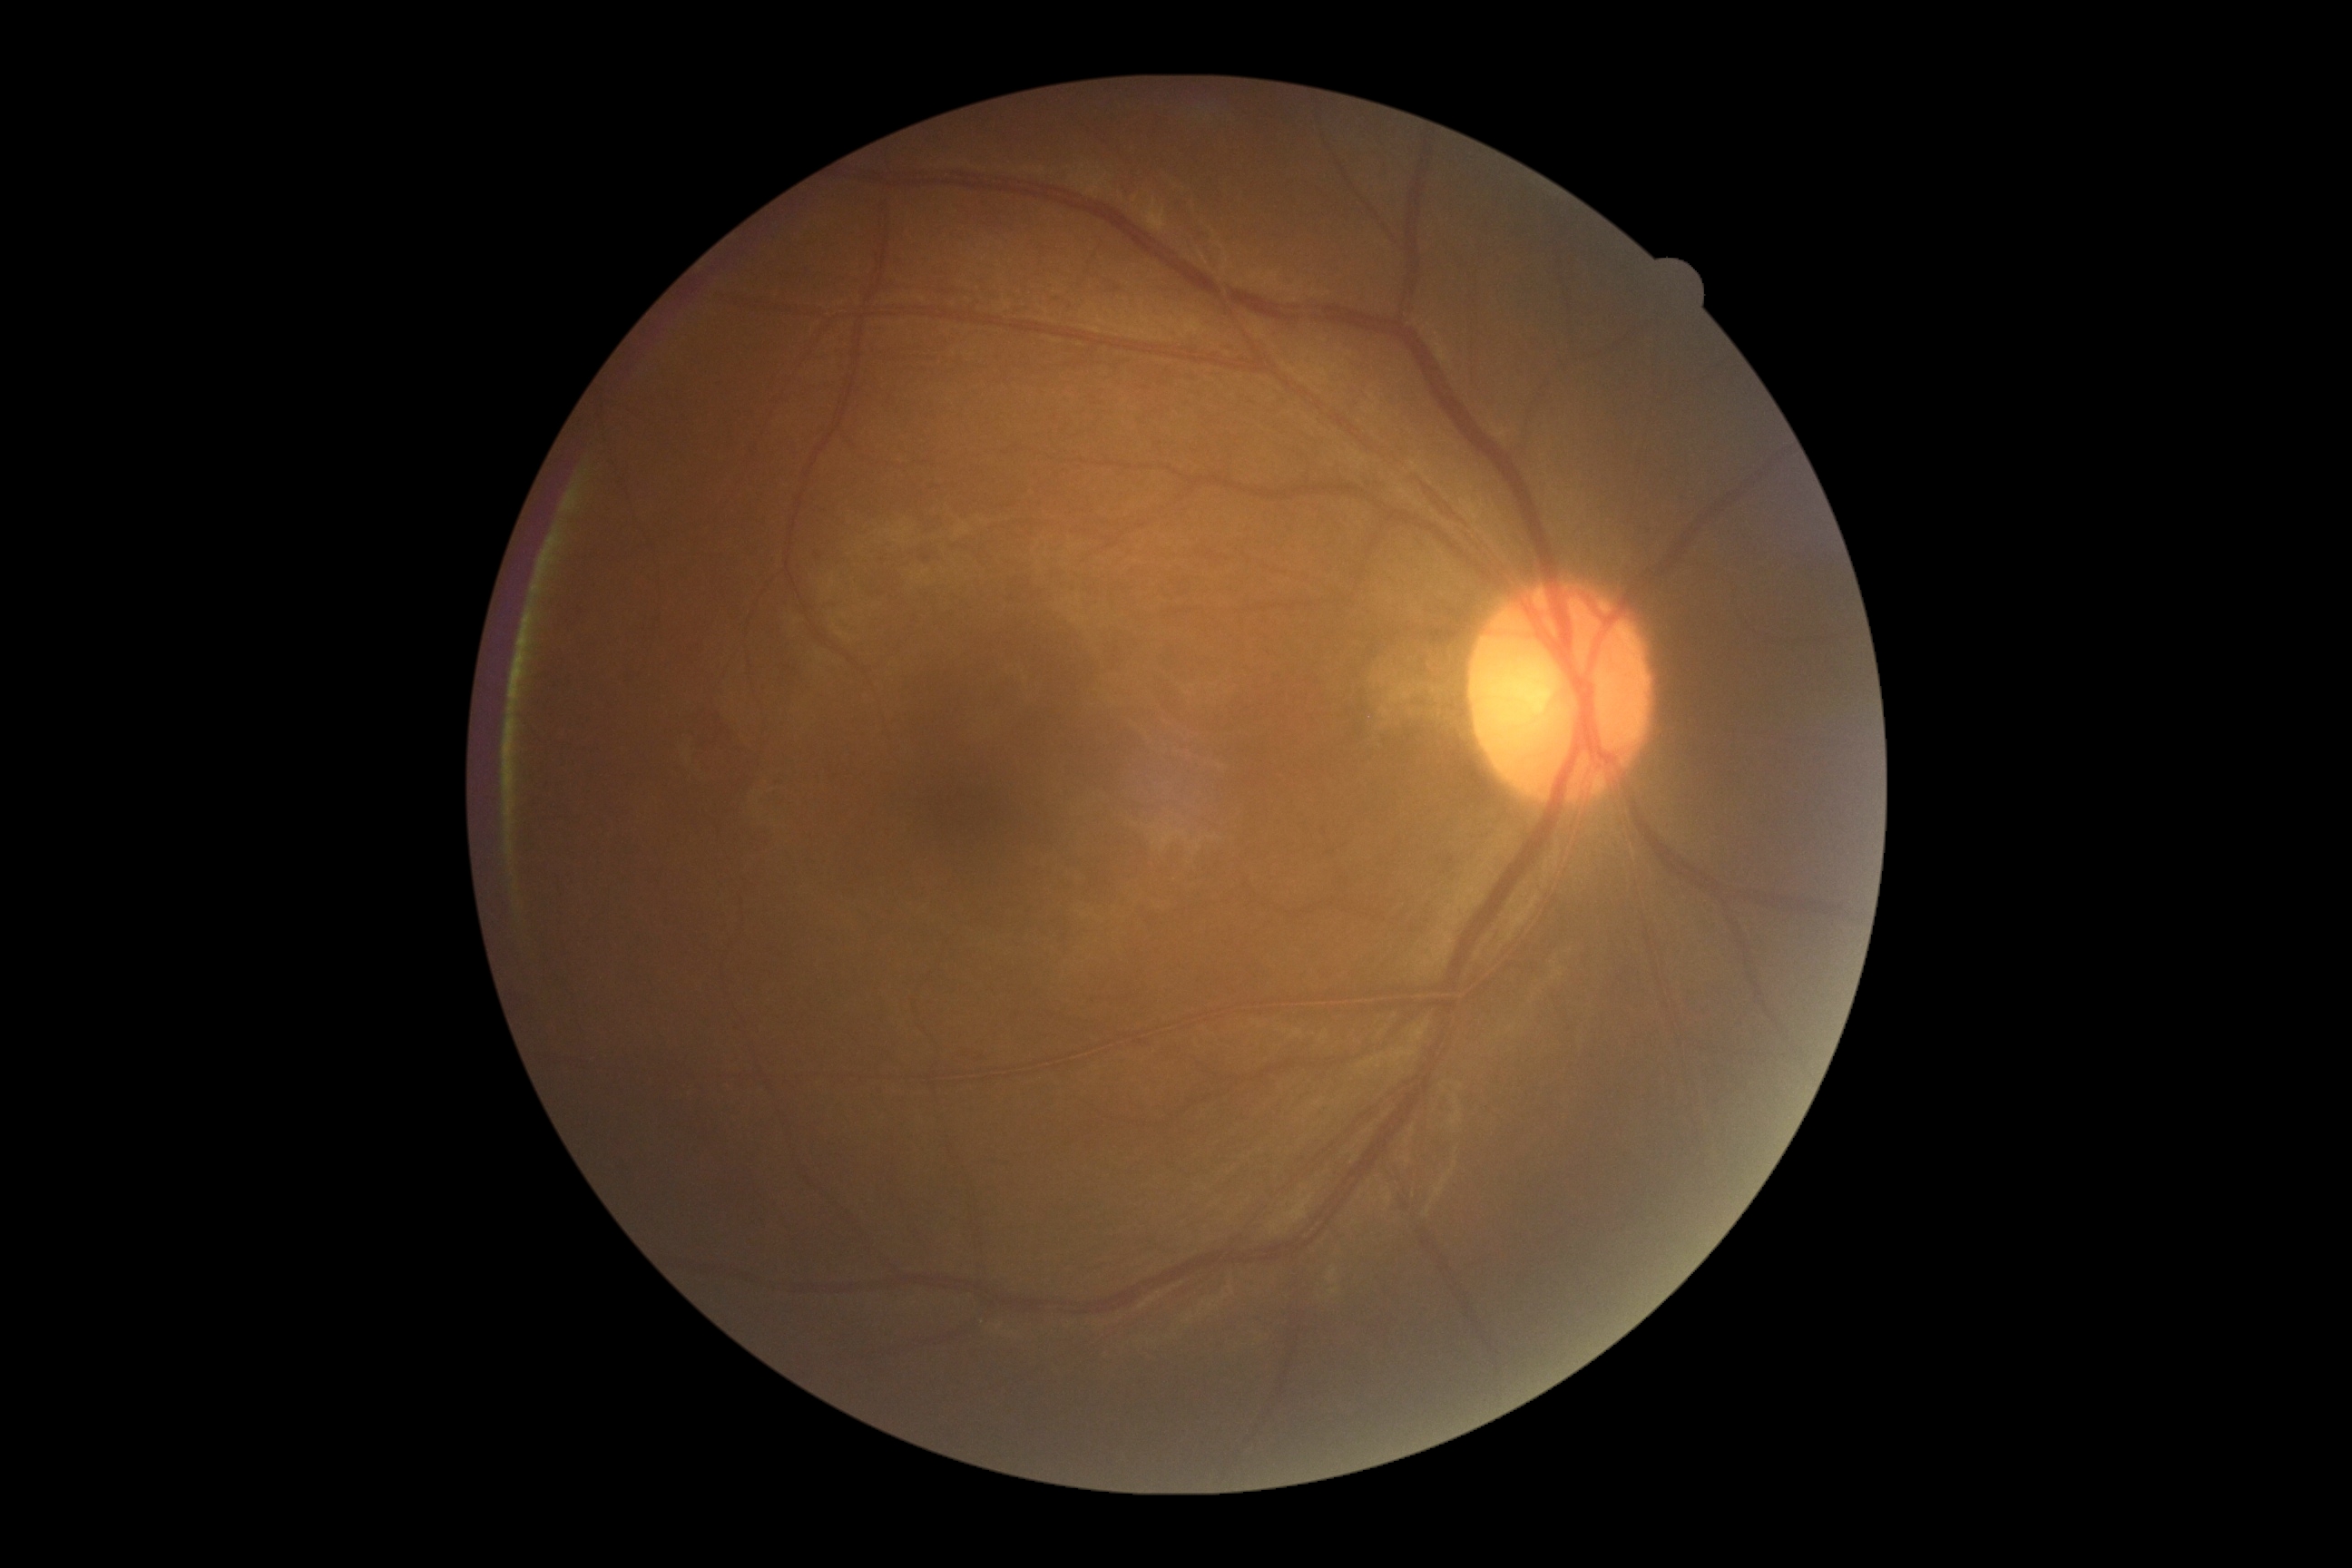

Diabetic retinopathy severity: grade 0 (no apparent retinopathy).